Acquired on the Phoenix ICON. Infant wide-field fundus photograph
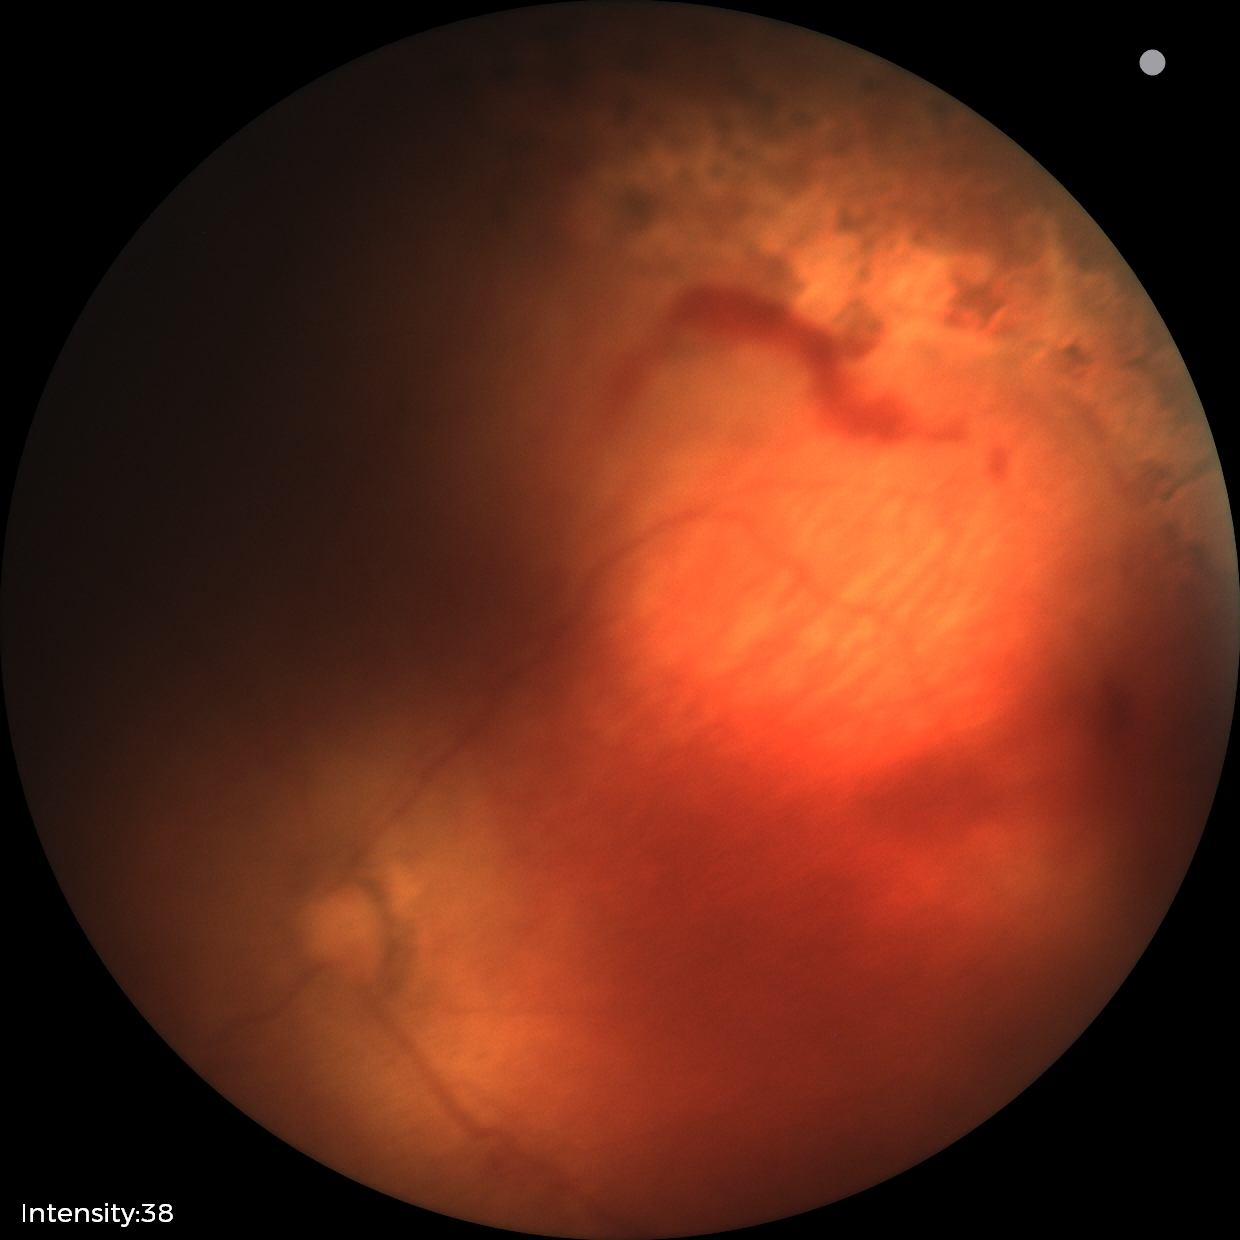
Impression: no plus disease; status post retinopathy of prematurity — retinal appearance after treated retinopathy of prematurity.